Fundus photo.
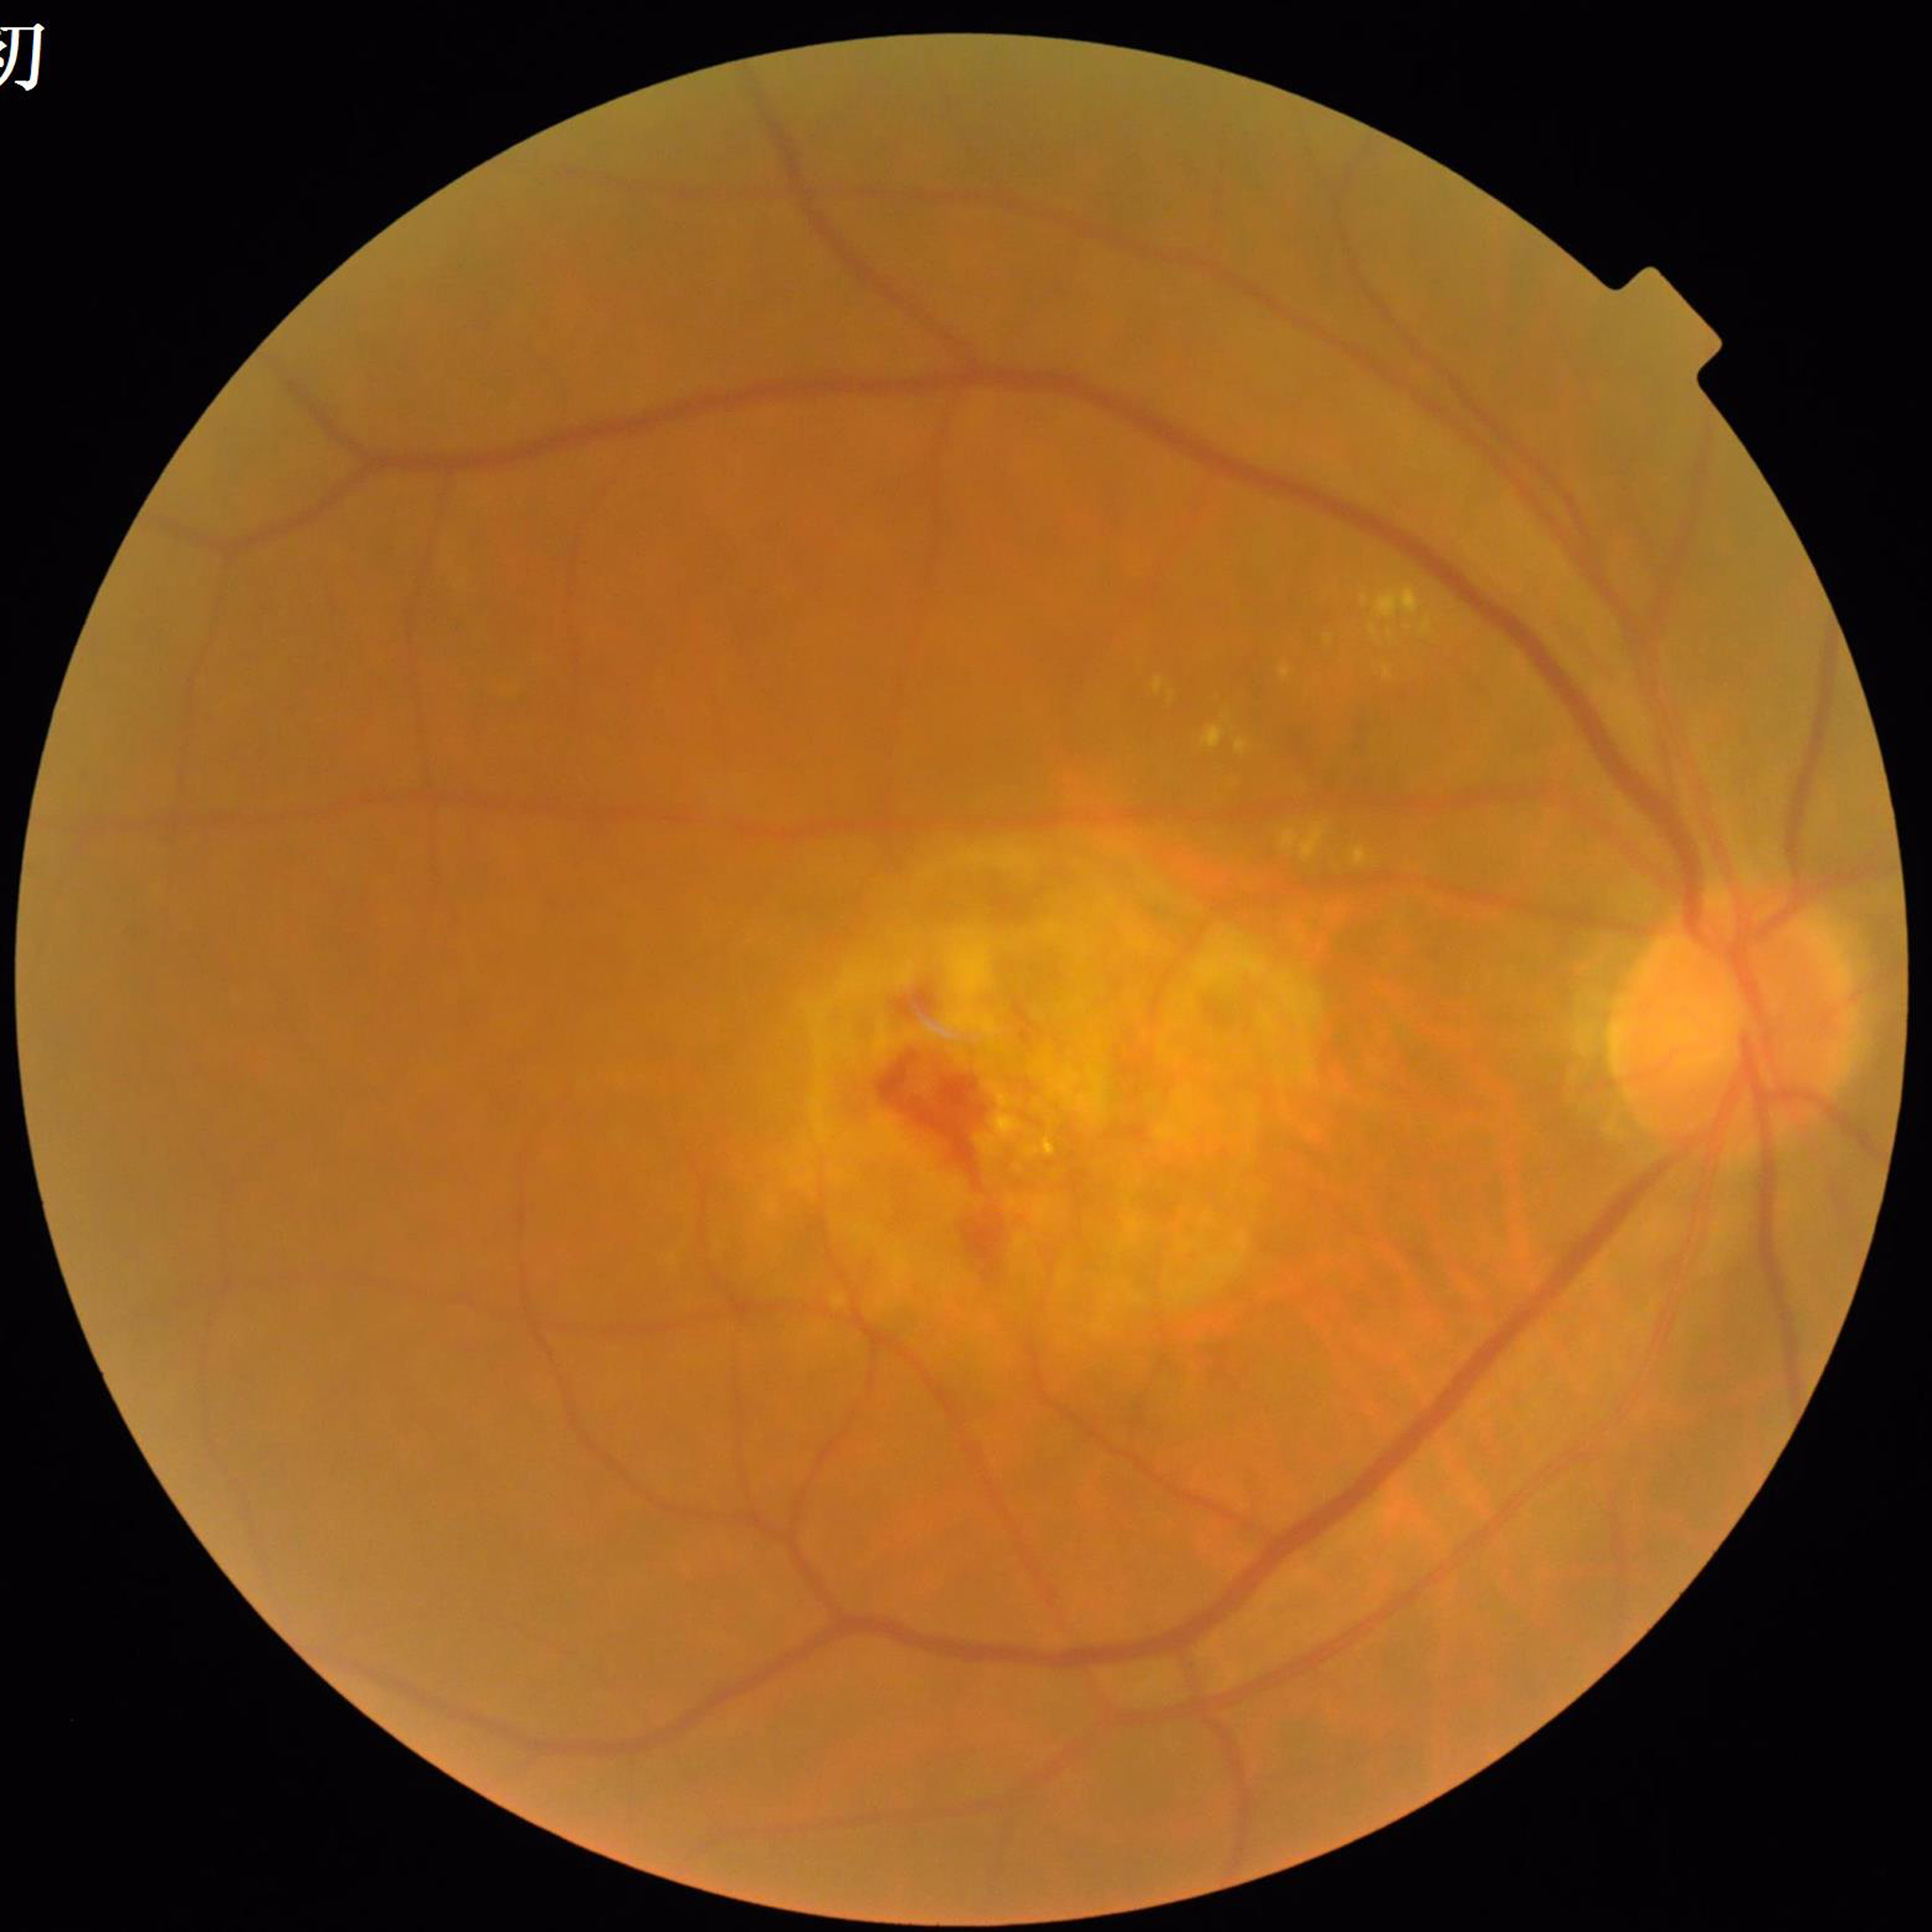
  diagnosis: age-related macular degeneration